Camera: NIDEK AFC-230. Color fundus image. 848 x 848 pixels. Nonmydriatic fundus photograph. 45° FOV. Modified Davis classification: 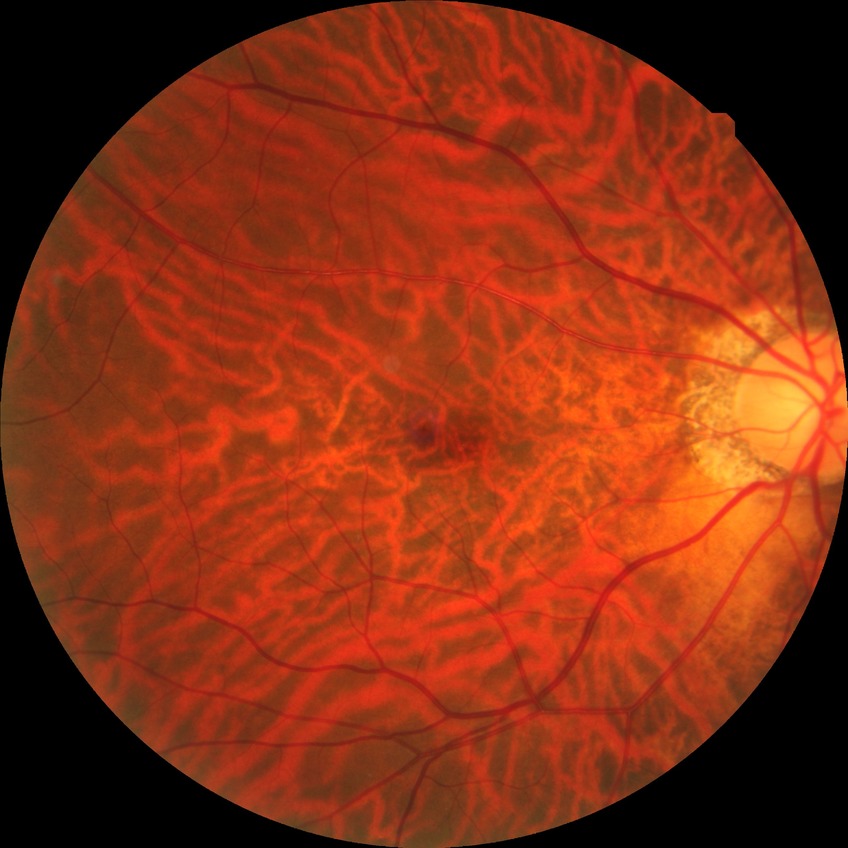

DR severity is NDR. No apparent diabetic retinopathy.